Modified Davis classification. 45° field of view: 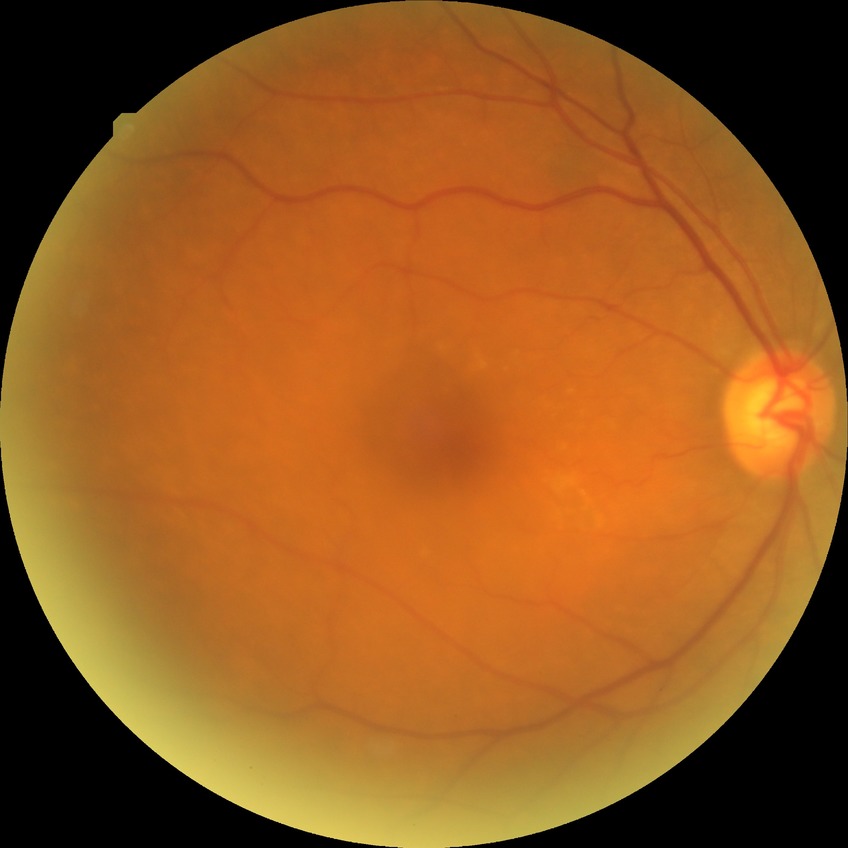

Diabetic retinopathy severity is no diabetic retinopathy.